45° FOV. Color fundus photograph. 1444 x 1444 pixels.
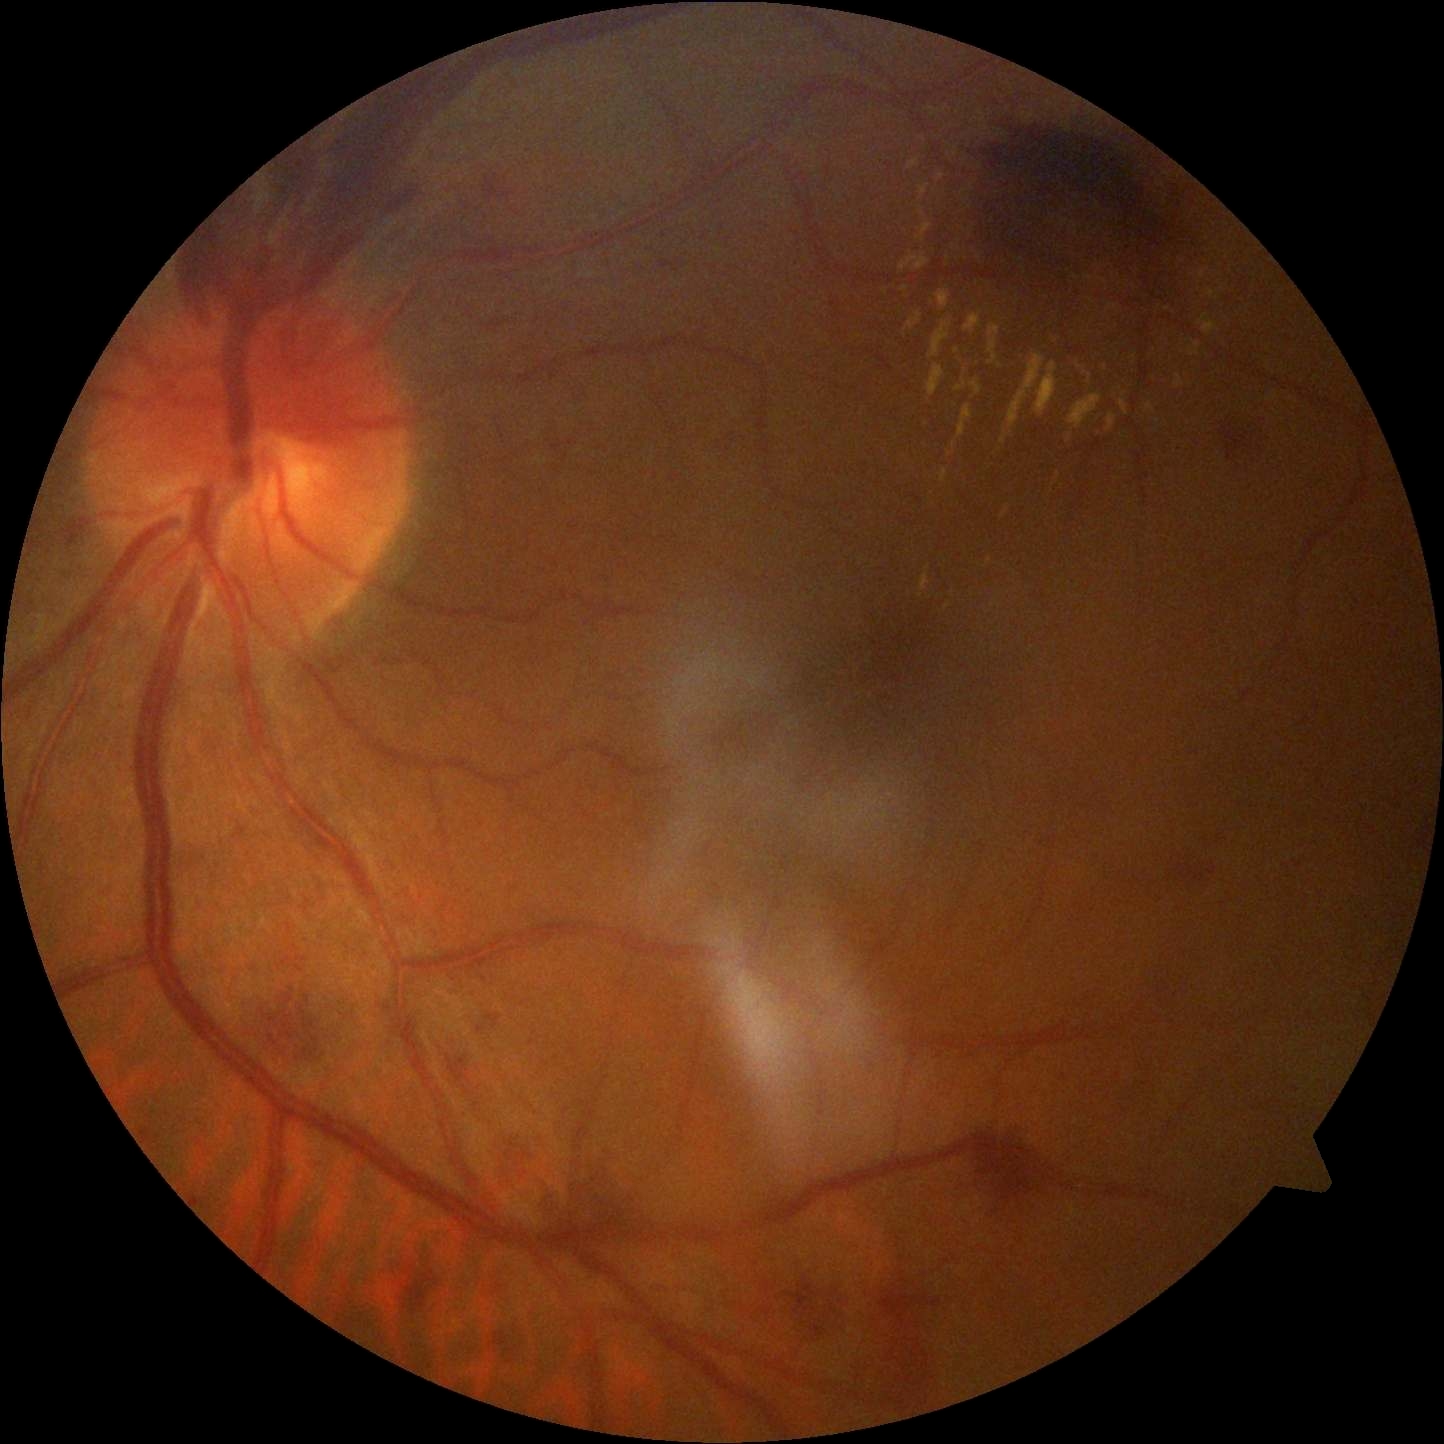 Disease class: proliferative diabetic retinopathy. Diabetic retinopathy grade is 4/4.